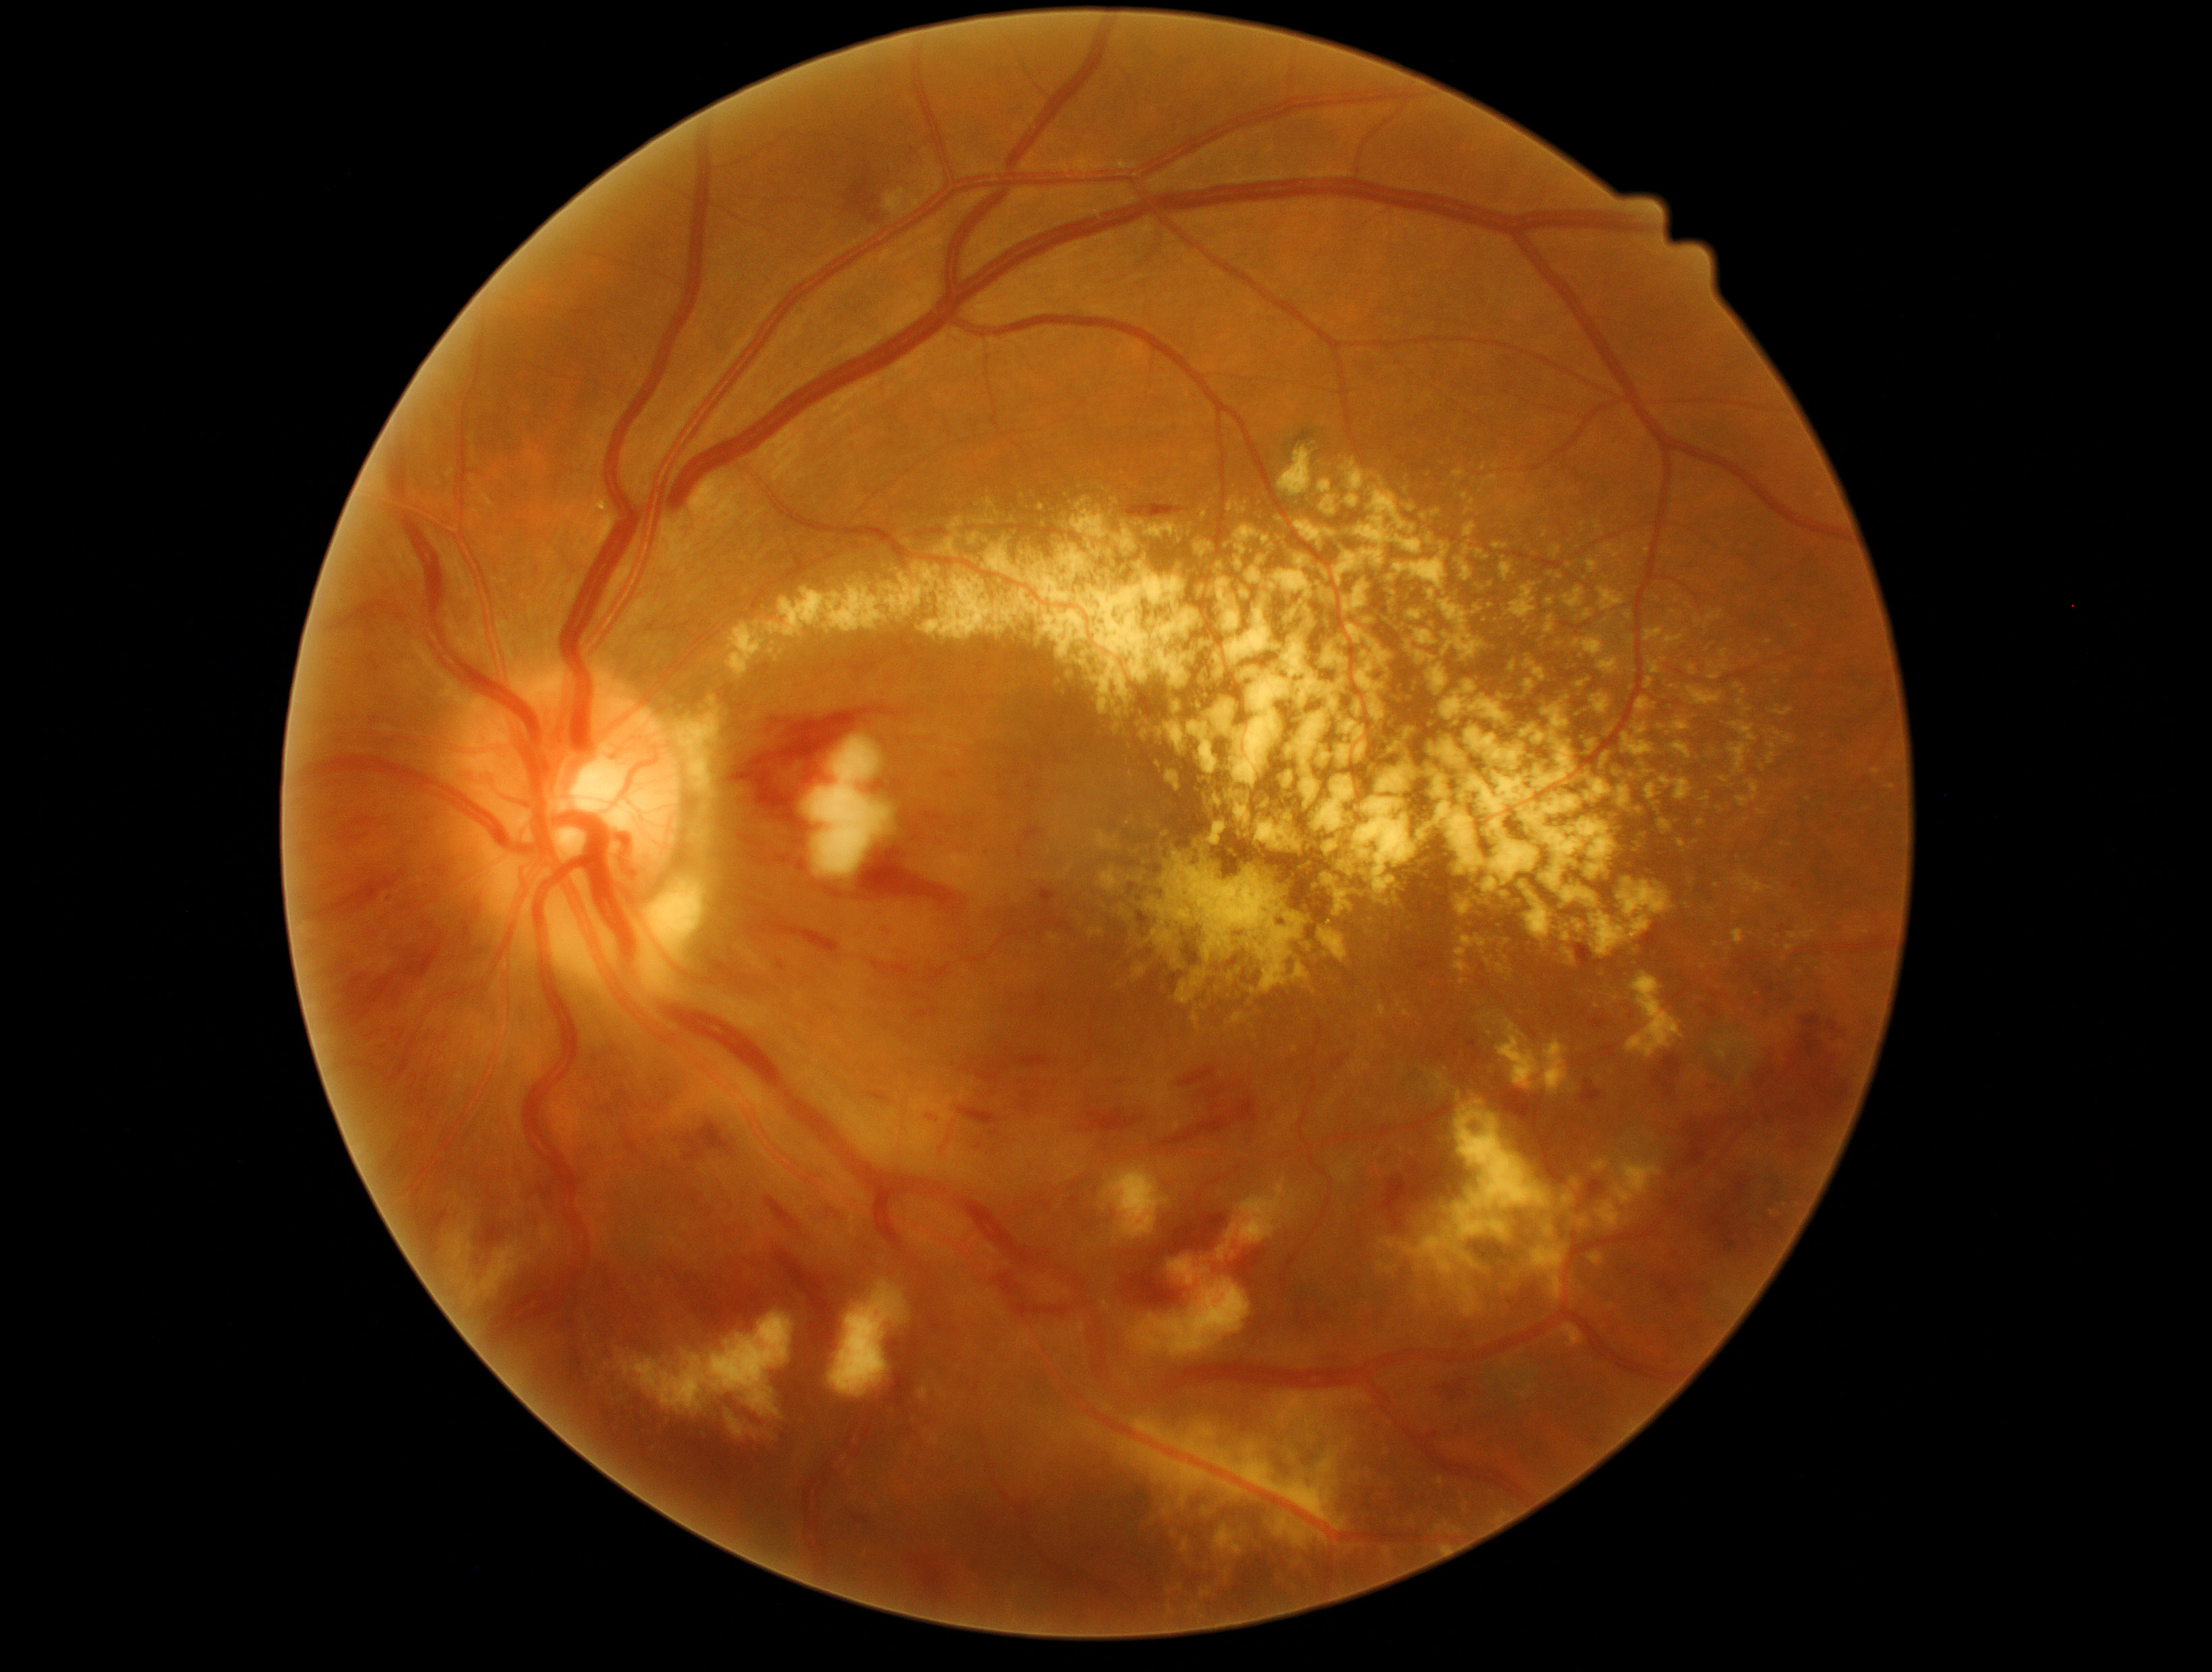

Diabetic retinopathy severity: 3
Selected lesions:
hard exudates (partial): (left=1665, top=775, right=1691, bottom=804), (left=1317, top=479, right=1341, bottom=496), (left=1430, top=1522, right=1464, bottom=1536), (left=1269, top=1550, right=1300, bottom=1582), (left=1112, top=723, right=1122, bottom=736), (left=1457, top=1094, right=1463, bottom=1102), (left=1657, top=820, right=1670, bottom=839), (left=935, top=535, right=961, bottom=558), (left=1772, top=709, right=1793, bottom=717), (left=1274, top=1392, right=1370, bottom=1431), (left=1648, top=1135, right=1656, bottom=1141), (left=1490, top=543, right=1511, bottom=556), (left=1050, top=934, right=1059, bottom=943), (left=1619, top=757, right=1662, bottom=804), (left=1590, top=1253, right=1604, bottom=1267), (left=1521, top=656, right=1550, bottom=706), (left=1525, top=725, right=1641, bottom=820), (left=1238, top=541, right=1405, bottom=769)
Small hard exudates near (1132, 776), (1747, 820)
hemorrhages (partial): (left=892, top=965, right=918, bottom=982), (left=1720, top=1120, right=1727, bottom=1131), (left=1700, top=1004, right=1718, bottom=1017), (left=958, top=1108, right=1001, bottom=1125), (left=1650, top=1275, right=1681, bottom=1305), (left=775, top=1251, right=841, bottom=1407), (left=396, top=1034, right=404, bottom=1047), (left=604, top=1071, right=608, bottom=1079), (left=916, top=1106, right=952, bottom=1139), (left=1471, top=1052, right=1482, bottom=1069), (left=1590, top=1016, right=1607, bottom=1032), (left=906, top=1554, right=952, bottom=1597), (left=1759, top=1061, right=1850, bottom=1125), (left=618, top=1086, right=635, bottom=1108), (left=1581, top=1079, right=1603, bottom=1105), (left=845, top=179, right=880, bottom=223), (left=961, top=1054, right=1055, bottom=1085), (left=1653, top=1054, right=1683, bottom=1098)